45 degree fundus photograph; 848x848:
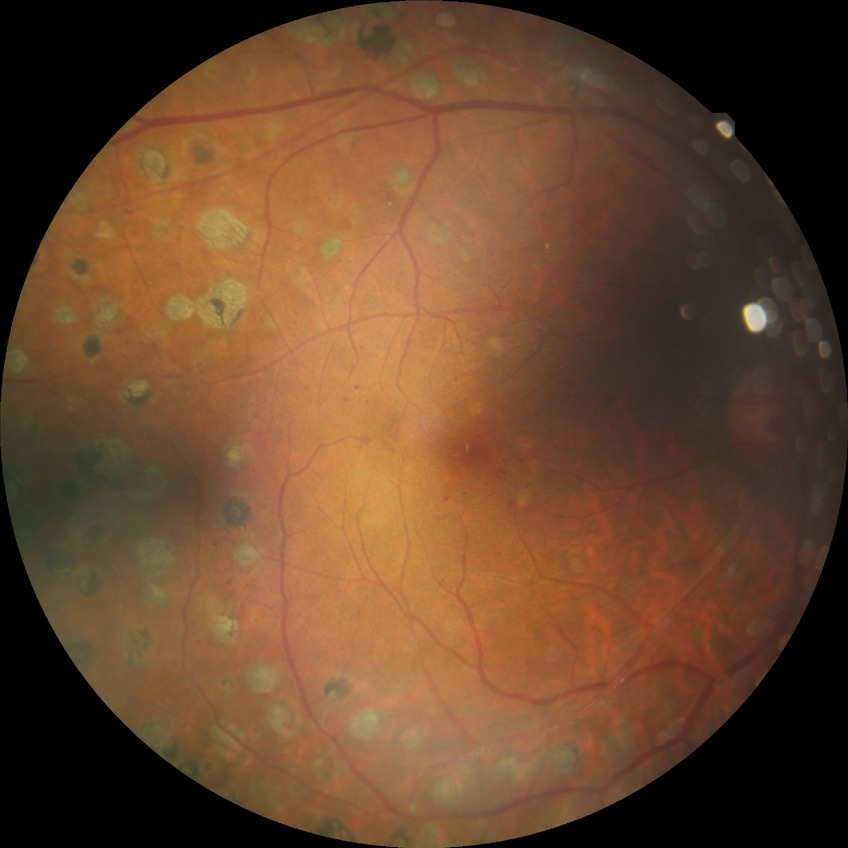

diabetic retinopathy grade = proliferative diabetic retinopathy.